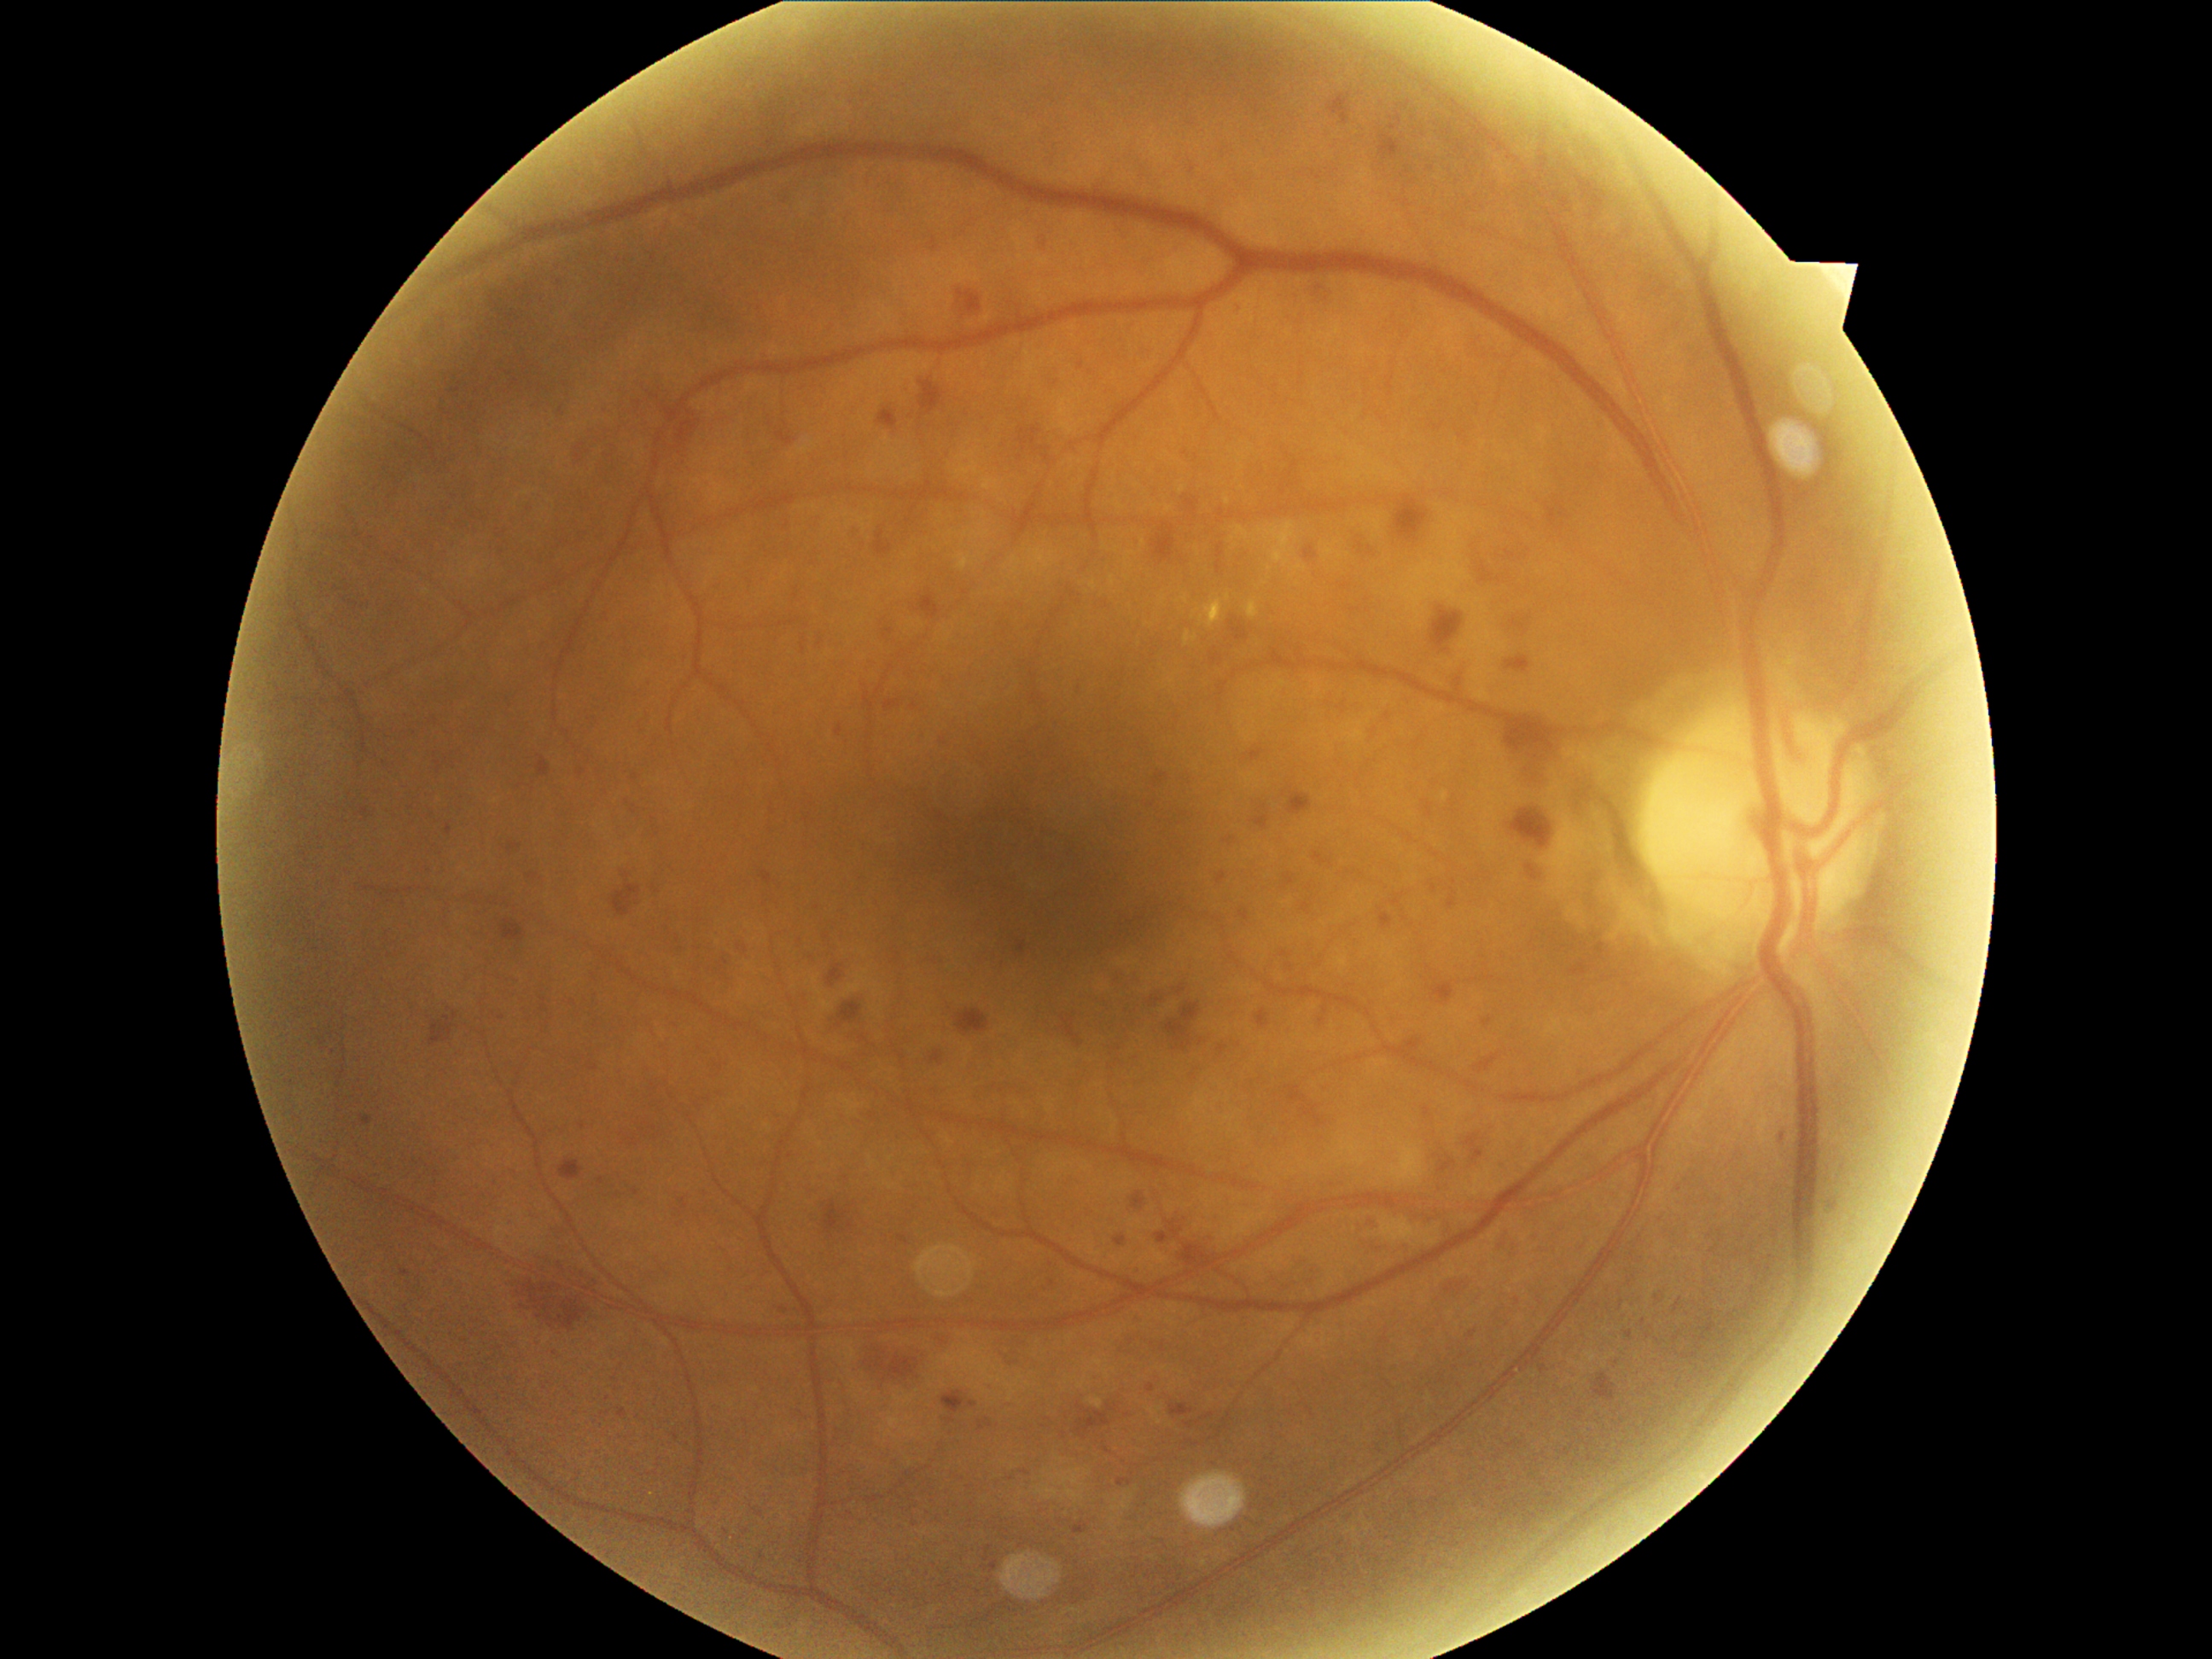
DR = severe non-proliferative diabetic retinopathy (grade 3).